Acquired on the Clarity RetCam 3; wide-field fundus photograph from neonatal ROP screening — 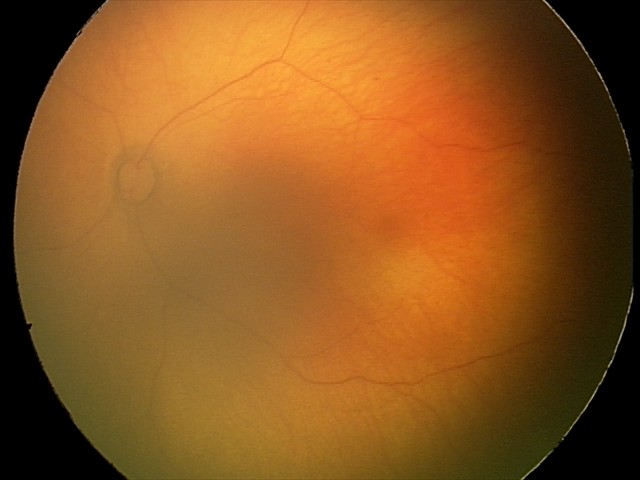
Physiological retinal appearance for postconceptual age.